Camera: Topcon TRC-50DX
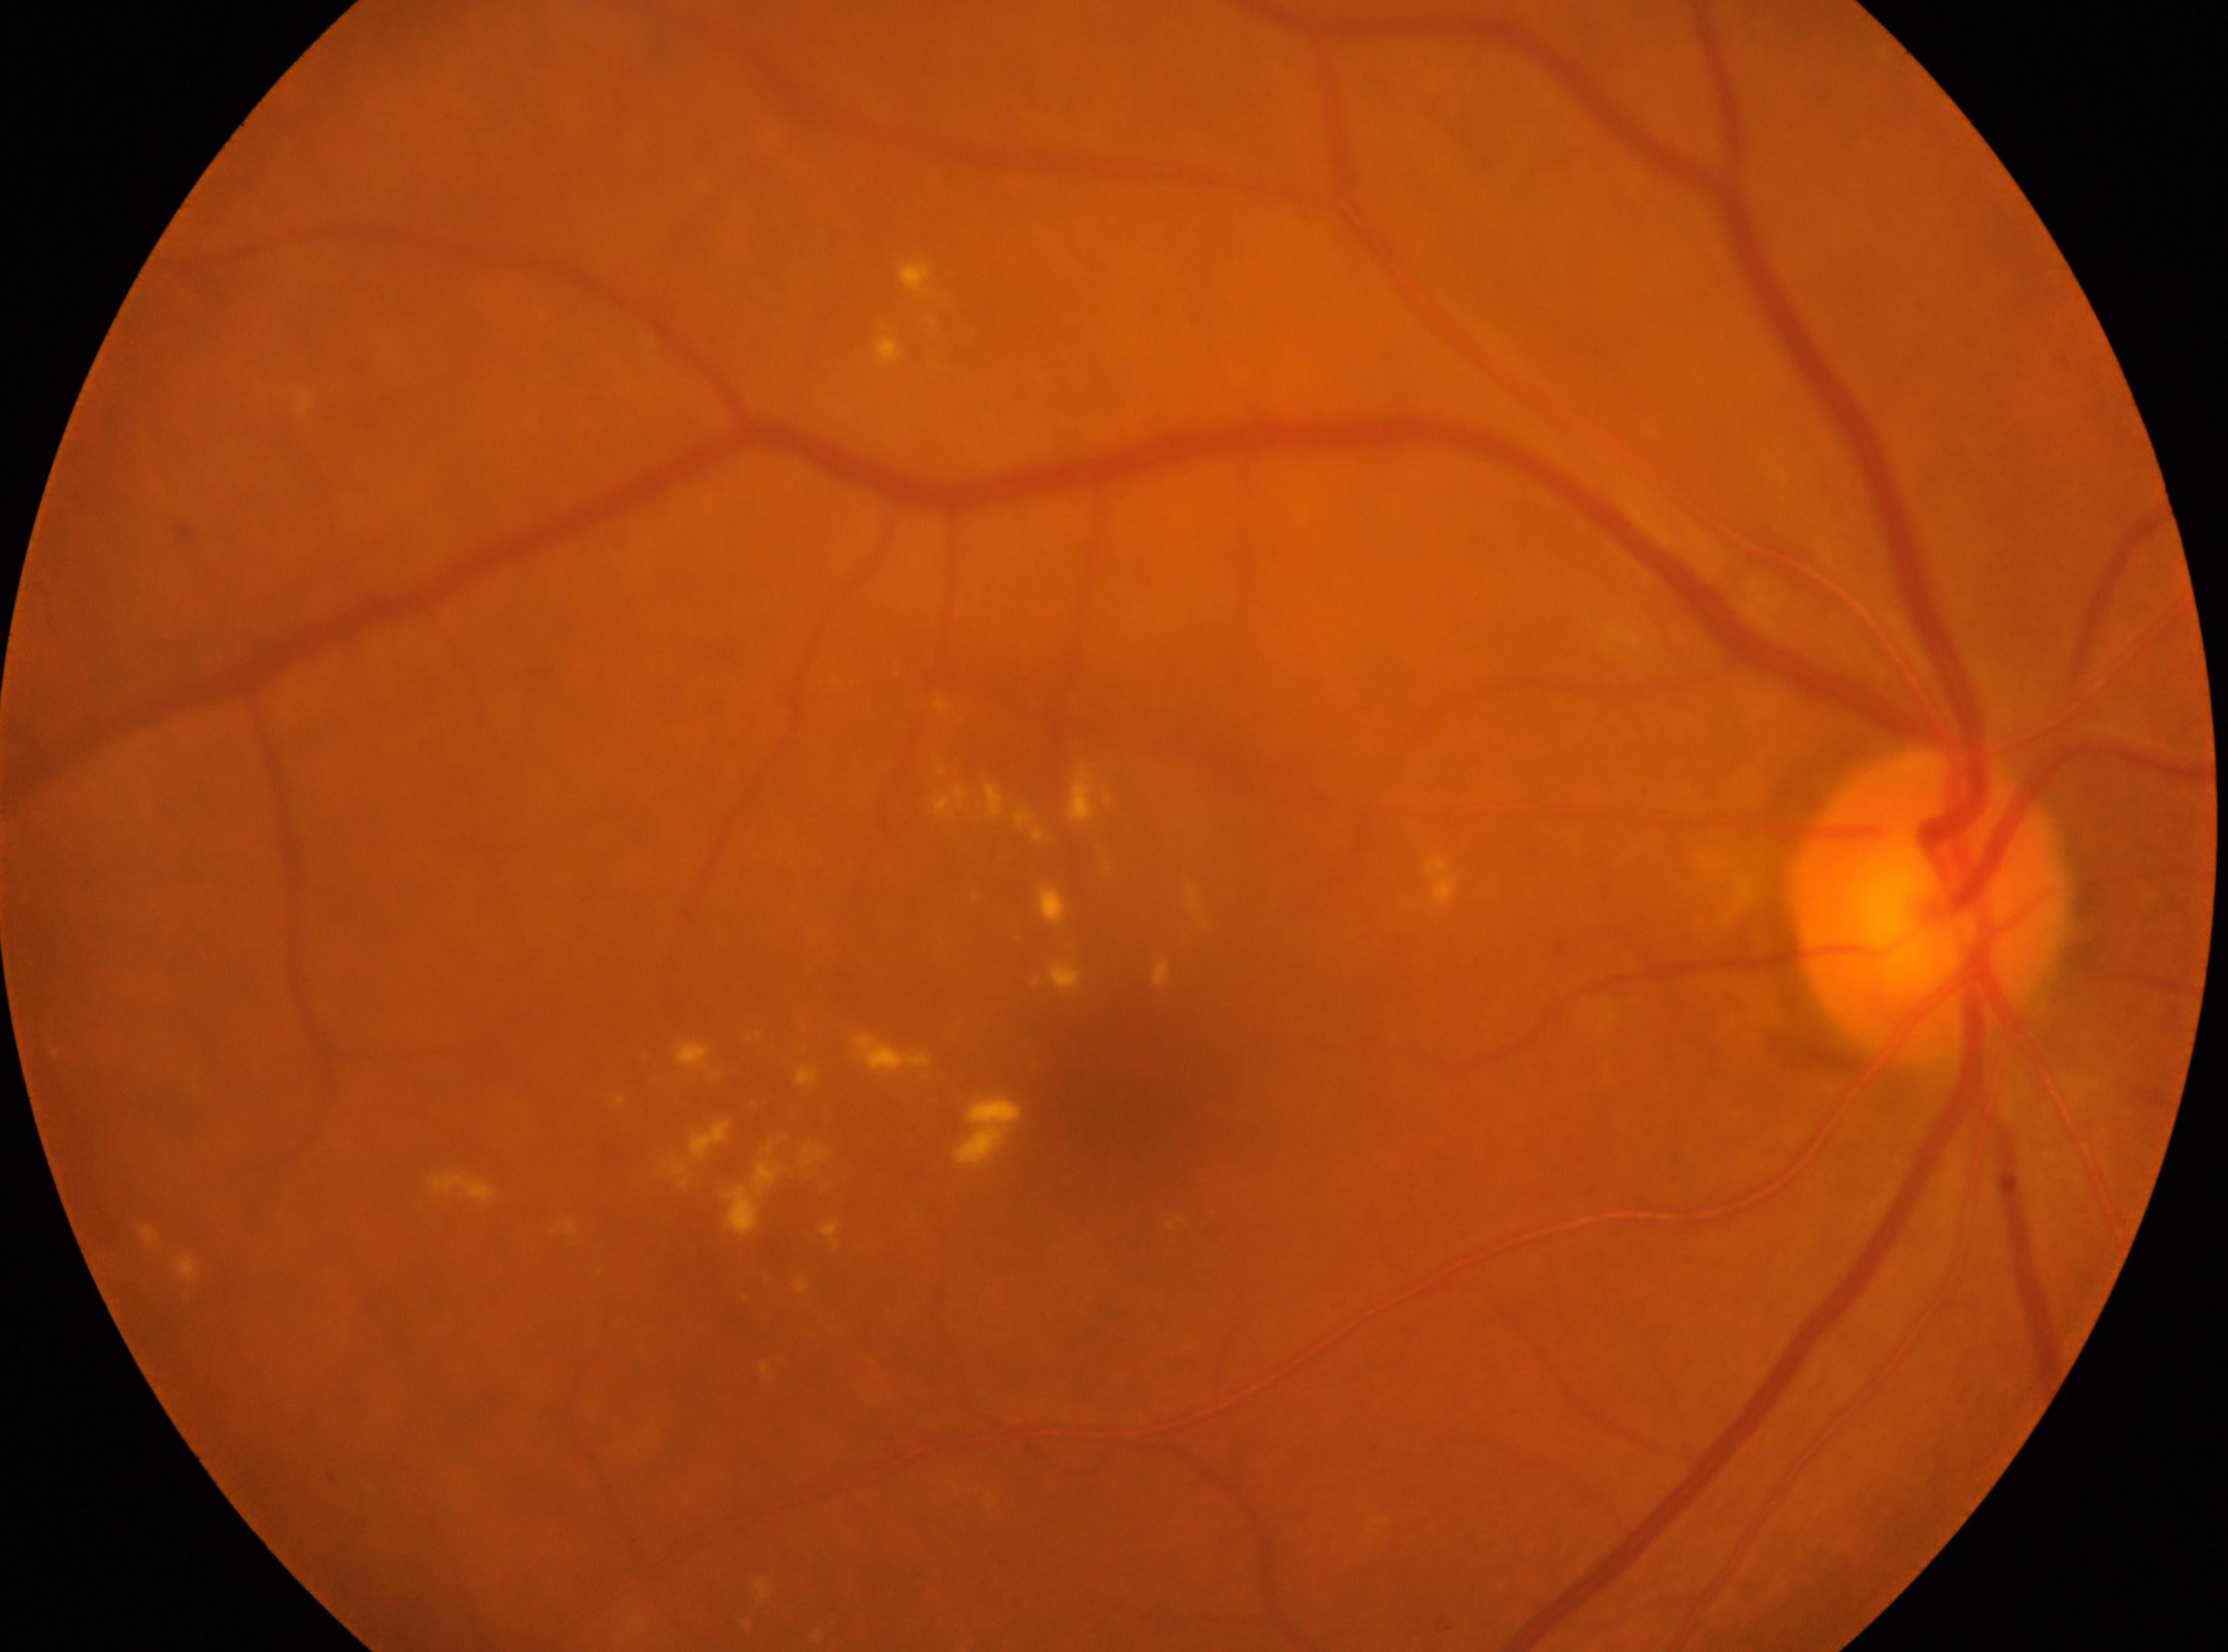
This is the right eye.
Diabetic retinopathy (DR): grade 2 (moderate NPDR).
Optic nerve head: (x: 1931, y: 906).
Macula center: (x: 1125, y: 1108).